Infant wide-field retinal image. 640x480px: 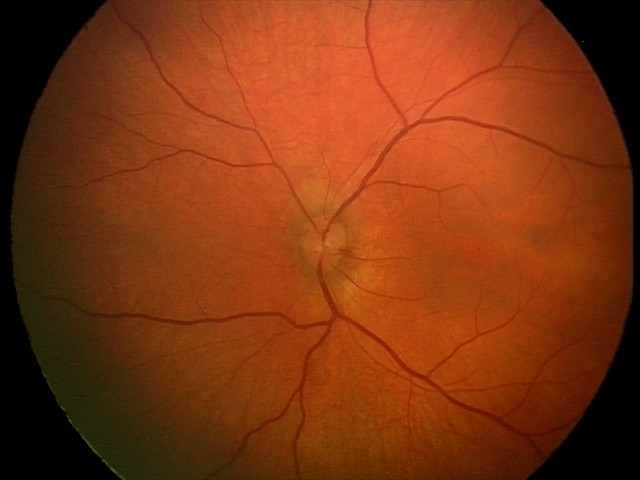
Screening examination consistent with retinal hemorrhages.